Infant wide-field fundus photograph.
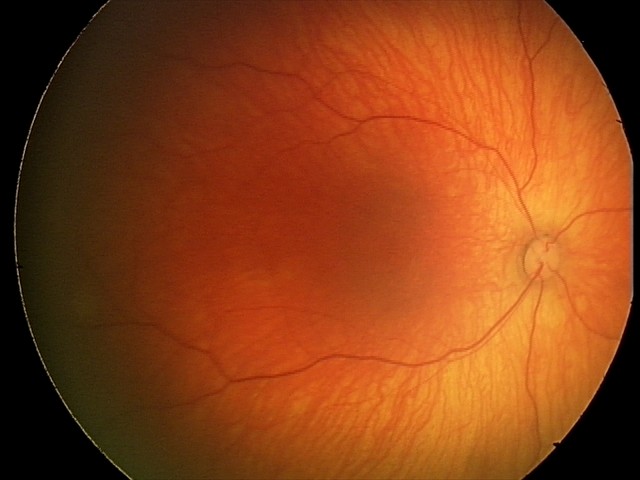 Screening examination diagnosed as physiological.